Phoenix ICON wide-field infant fundus image. 100° field of view (Phoenix ICON).
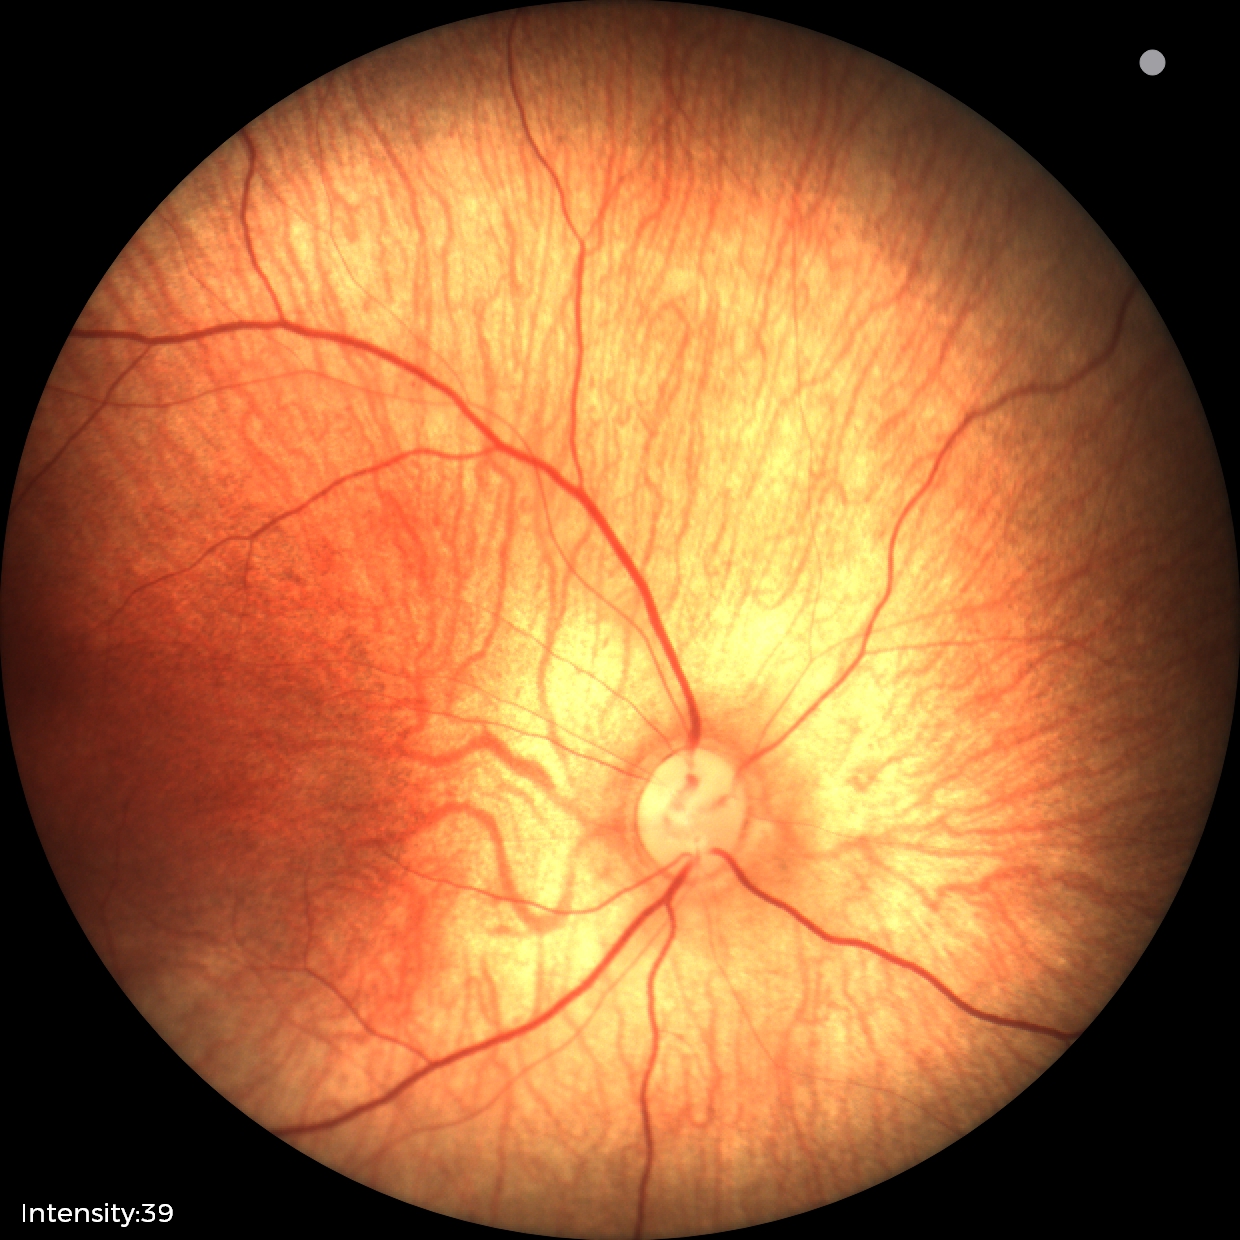 Screening diagnosis: physiological appearance.